640x480px. 130° field of view (Clarity RetCam 3). Infant wide-field fundus photograph — 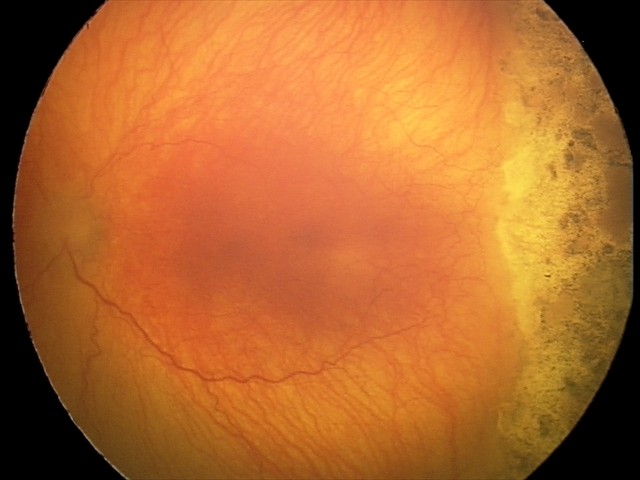

Diagnosis from this screening exam: aggressive retinopathy of prematurity (A-ROP).